2352 x 1568 pixels:
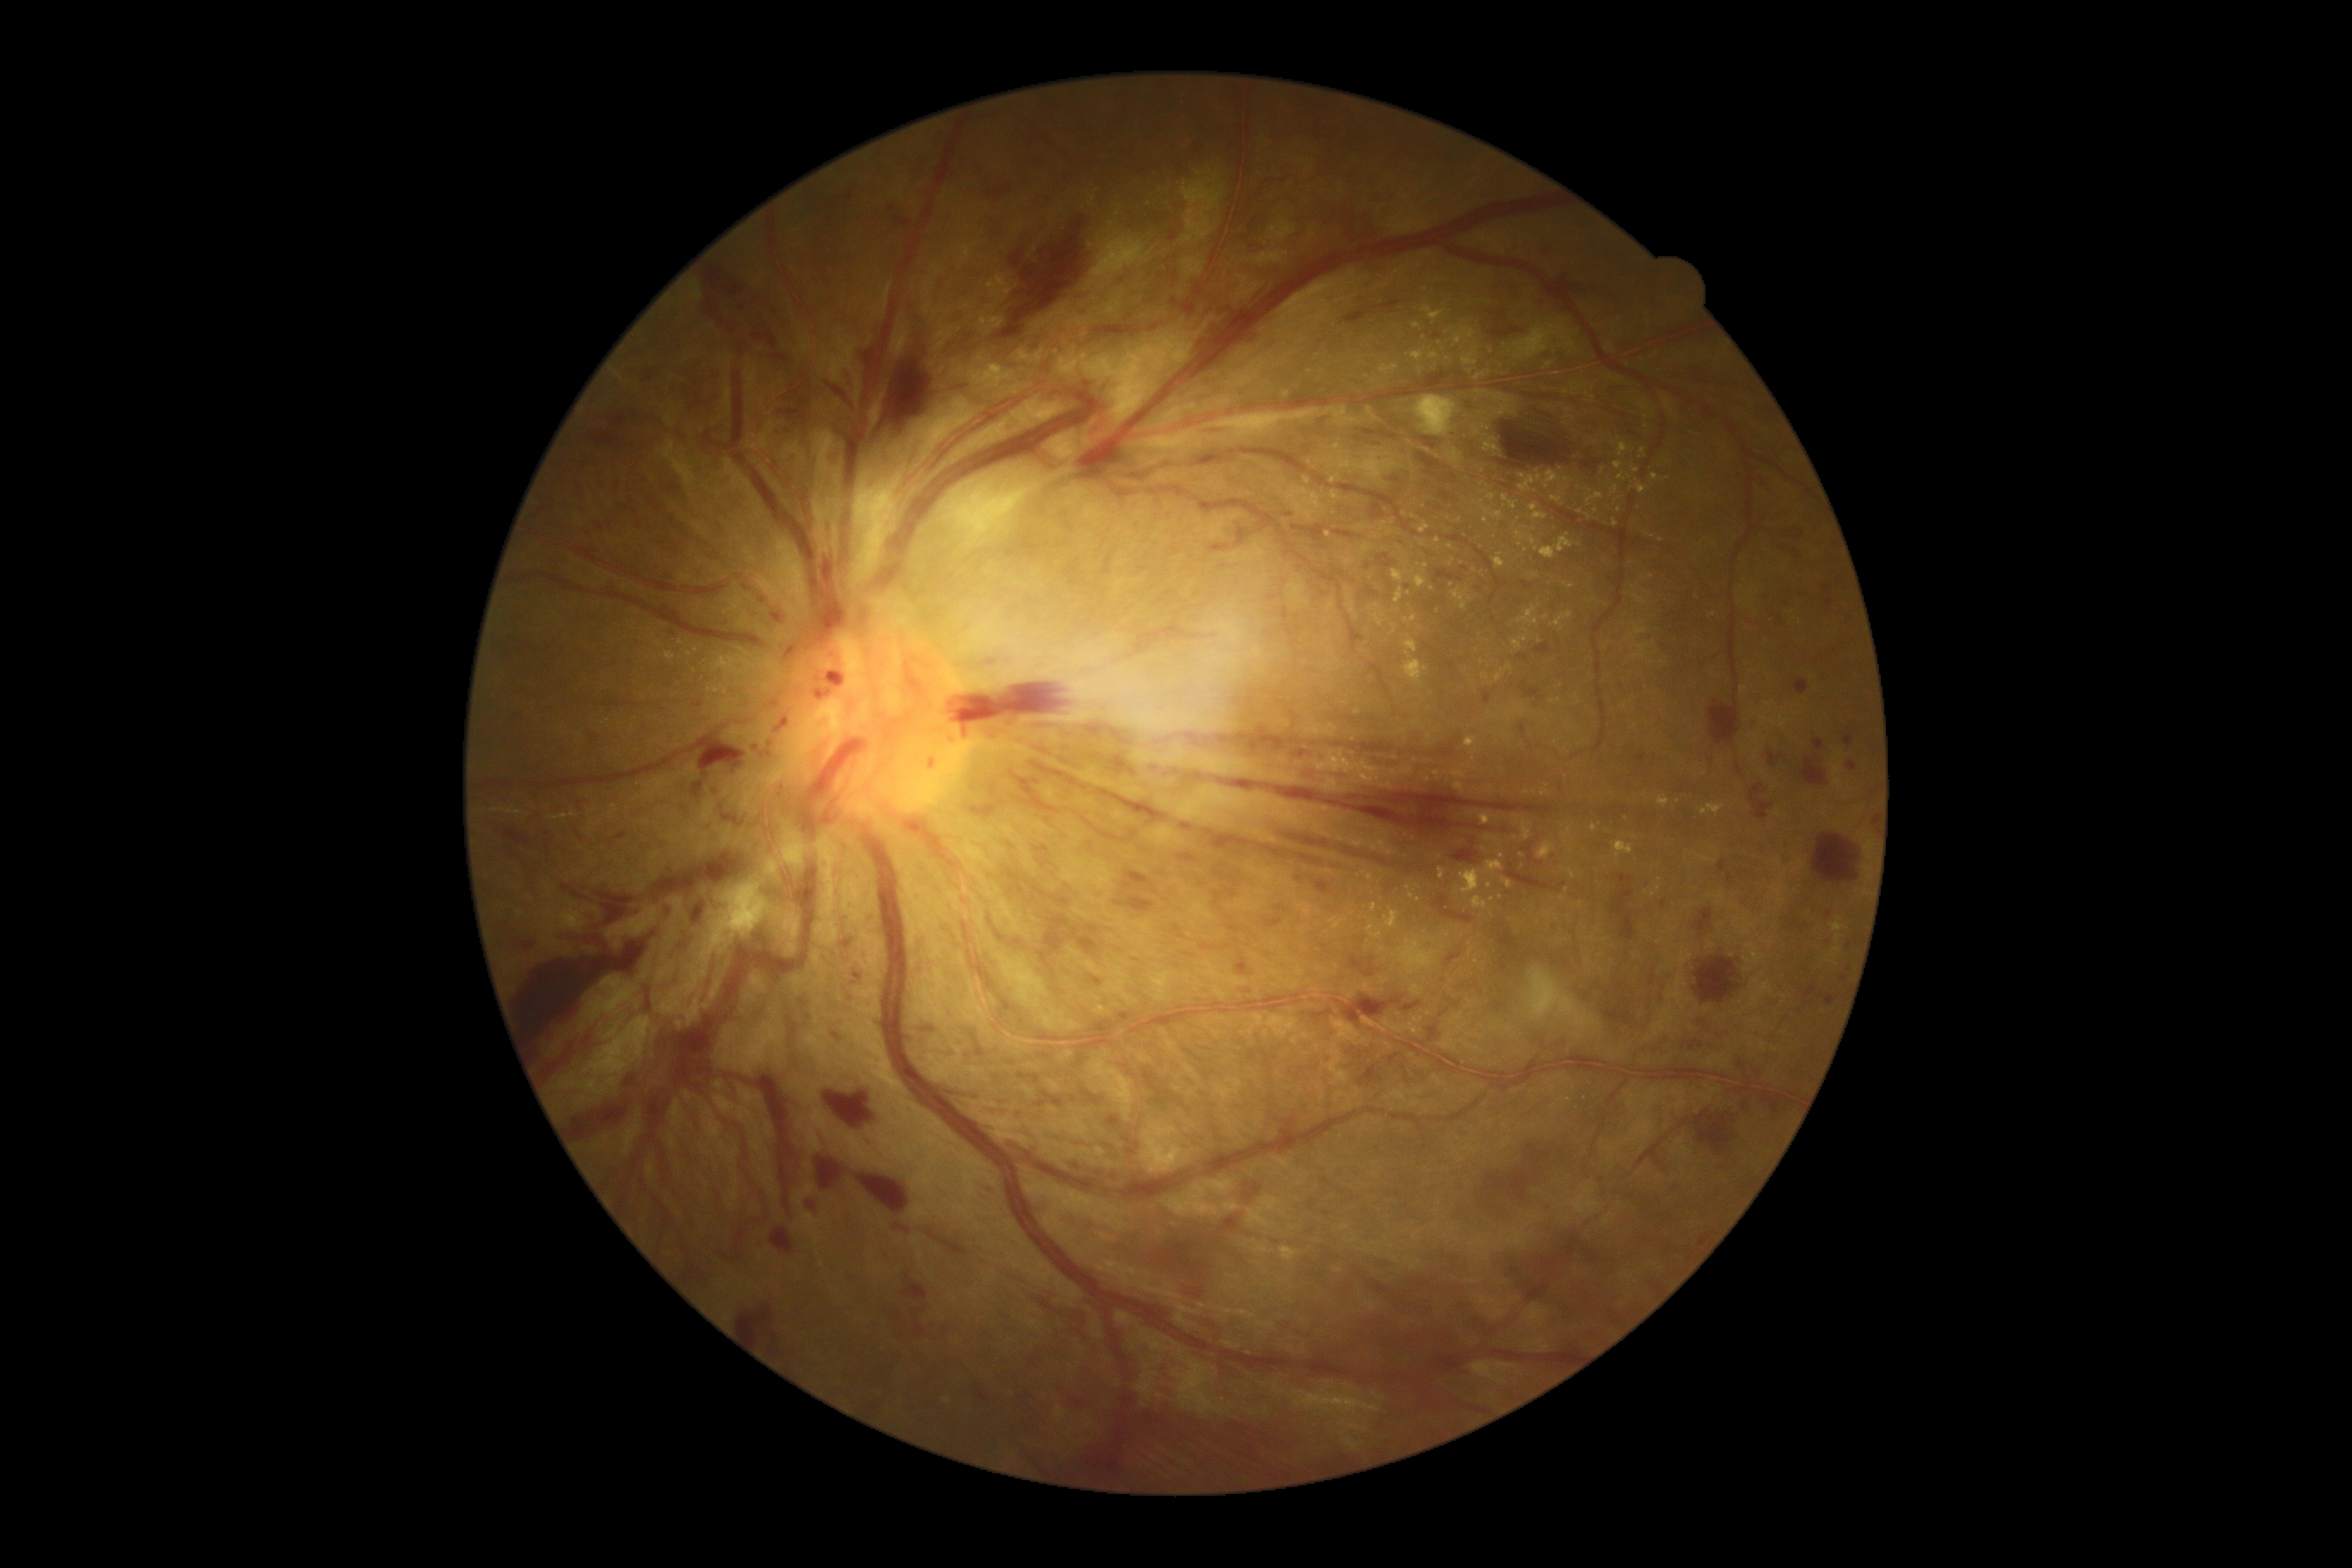
Diabetic retinopathy (DR): 4
Representative lesions:
* hemorrhages (HEs) (more not shown): bbox(690, 781, 704, 799); bbox(1001, 1137, 1032, 1155); bbox(1275, 907, 1287, 912); bbox(969, 1031, 976, 1044); bbox(723, 278, 749, 305); bbox(1485, 694, 1491, 706); bbox(1127, 623, 1197, 659); bbox(1452, 848, 1478, 864); bbox(897, 1225, 910, 1235); bbox(1404, 1001, 1423, 1012); bbox(775, 716, 790, 733); bbox(1218, 780, 1552, 833); bbox(738, 1304, 778, 1349); bbox(1087, 725, 1105, 735); bbox(824, 379, 857, 410); bbox(1314, 415, 1332, 422); bbox(1160, 1364, 1182, 1380)
* Small HEs approximately at point(1032, 141); point(1402, 866); point(1176, 772)
* hard exudates (EXs) (more not shown): bbox(1404, 637, 1418, 654); bbox(1560, 1098, 1571, 1103); bbox(1461, 862, 1505, 895); bbox(1381, 364, 1399, 376); bbox(1466, 738, 1478, 749); bbox(1357, 525, 1366, 532); bbox(1412, 324, 1421, 329); bbox(1330, 475, 1340, 484); bbox(1504, 665, 1512, 673); bbox(1631, 628, 1648, 637); bbox(1392, 568, 1416, 584)
* Small EXs approximately at point(1214, 1308); point(1151, 200); point(1370, 608); point(1519, 520); point(1331, 757); point(1428, 451); point(1616, 523); point(1346, 704); point(1567, 890)